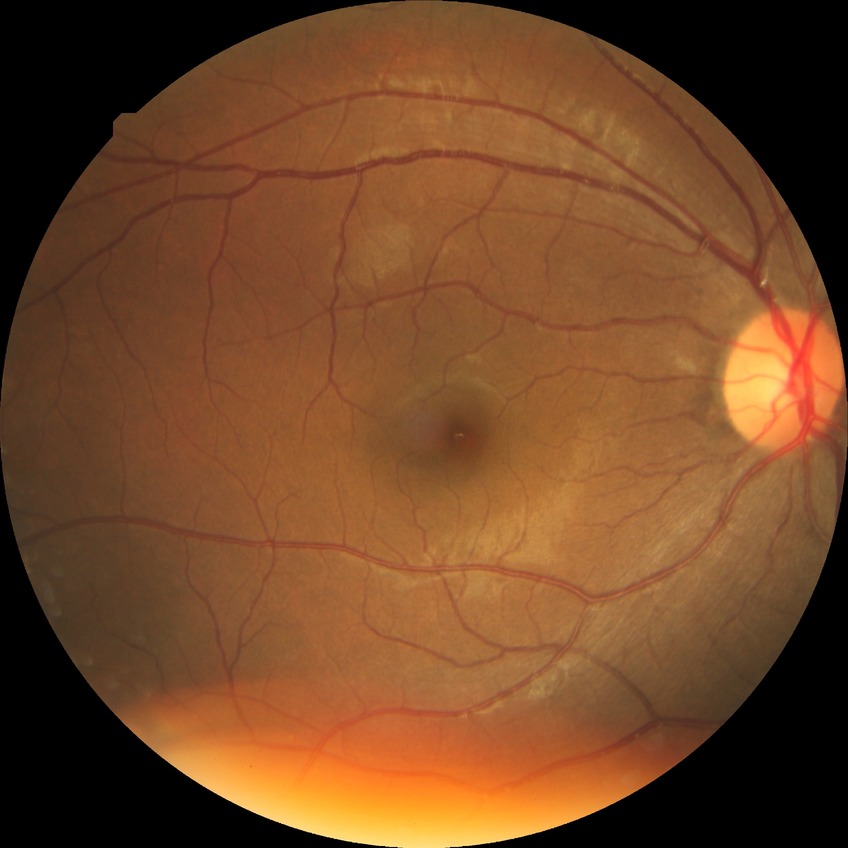
Diabetic retinopathy stage is simple diabetic retinopathy.